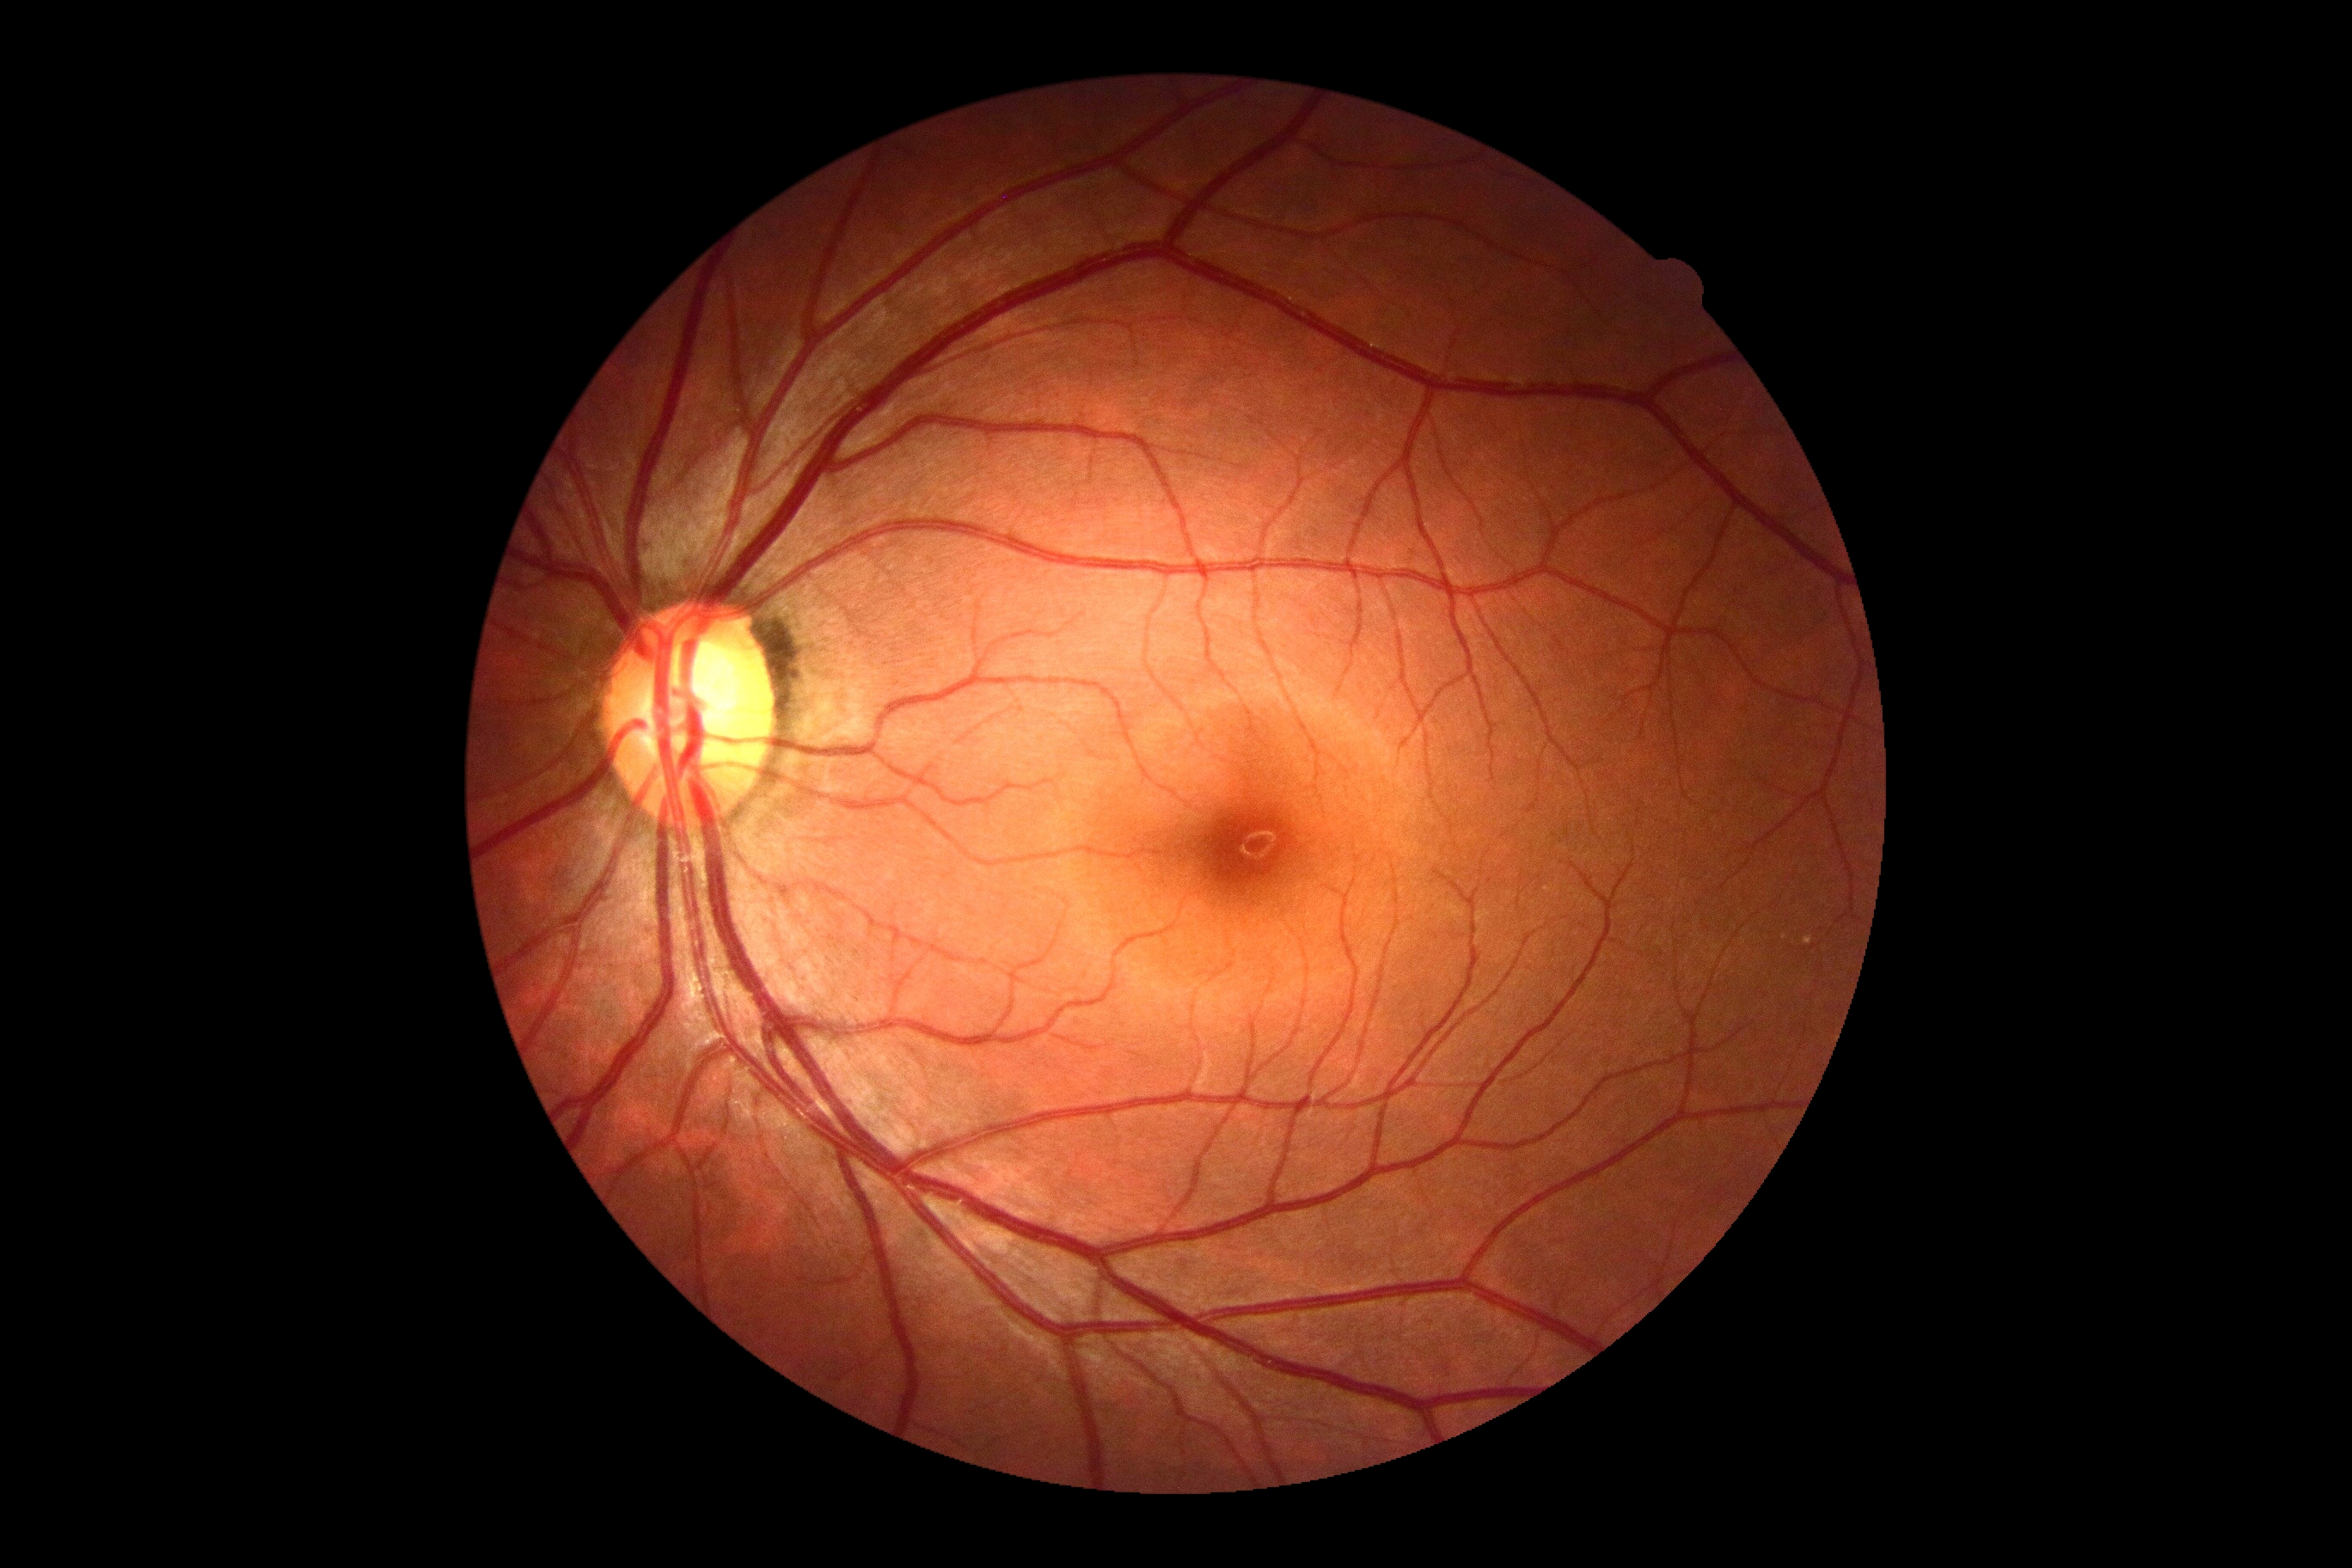

Diabetic retinopathy (DR): 0/4 — no visible signs of diabetic retinopathy.